Non-mydriatic acquisition
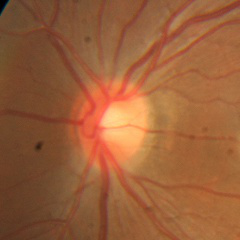 Q: Does this eye have glaucoma?
A: No glaucomatous optic neuropathy.